2048 x 1536 pixels
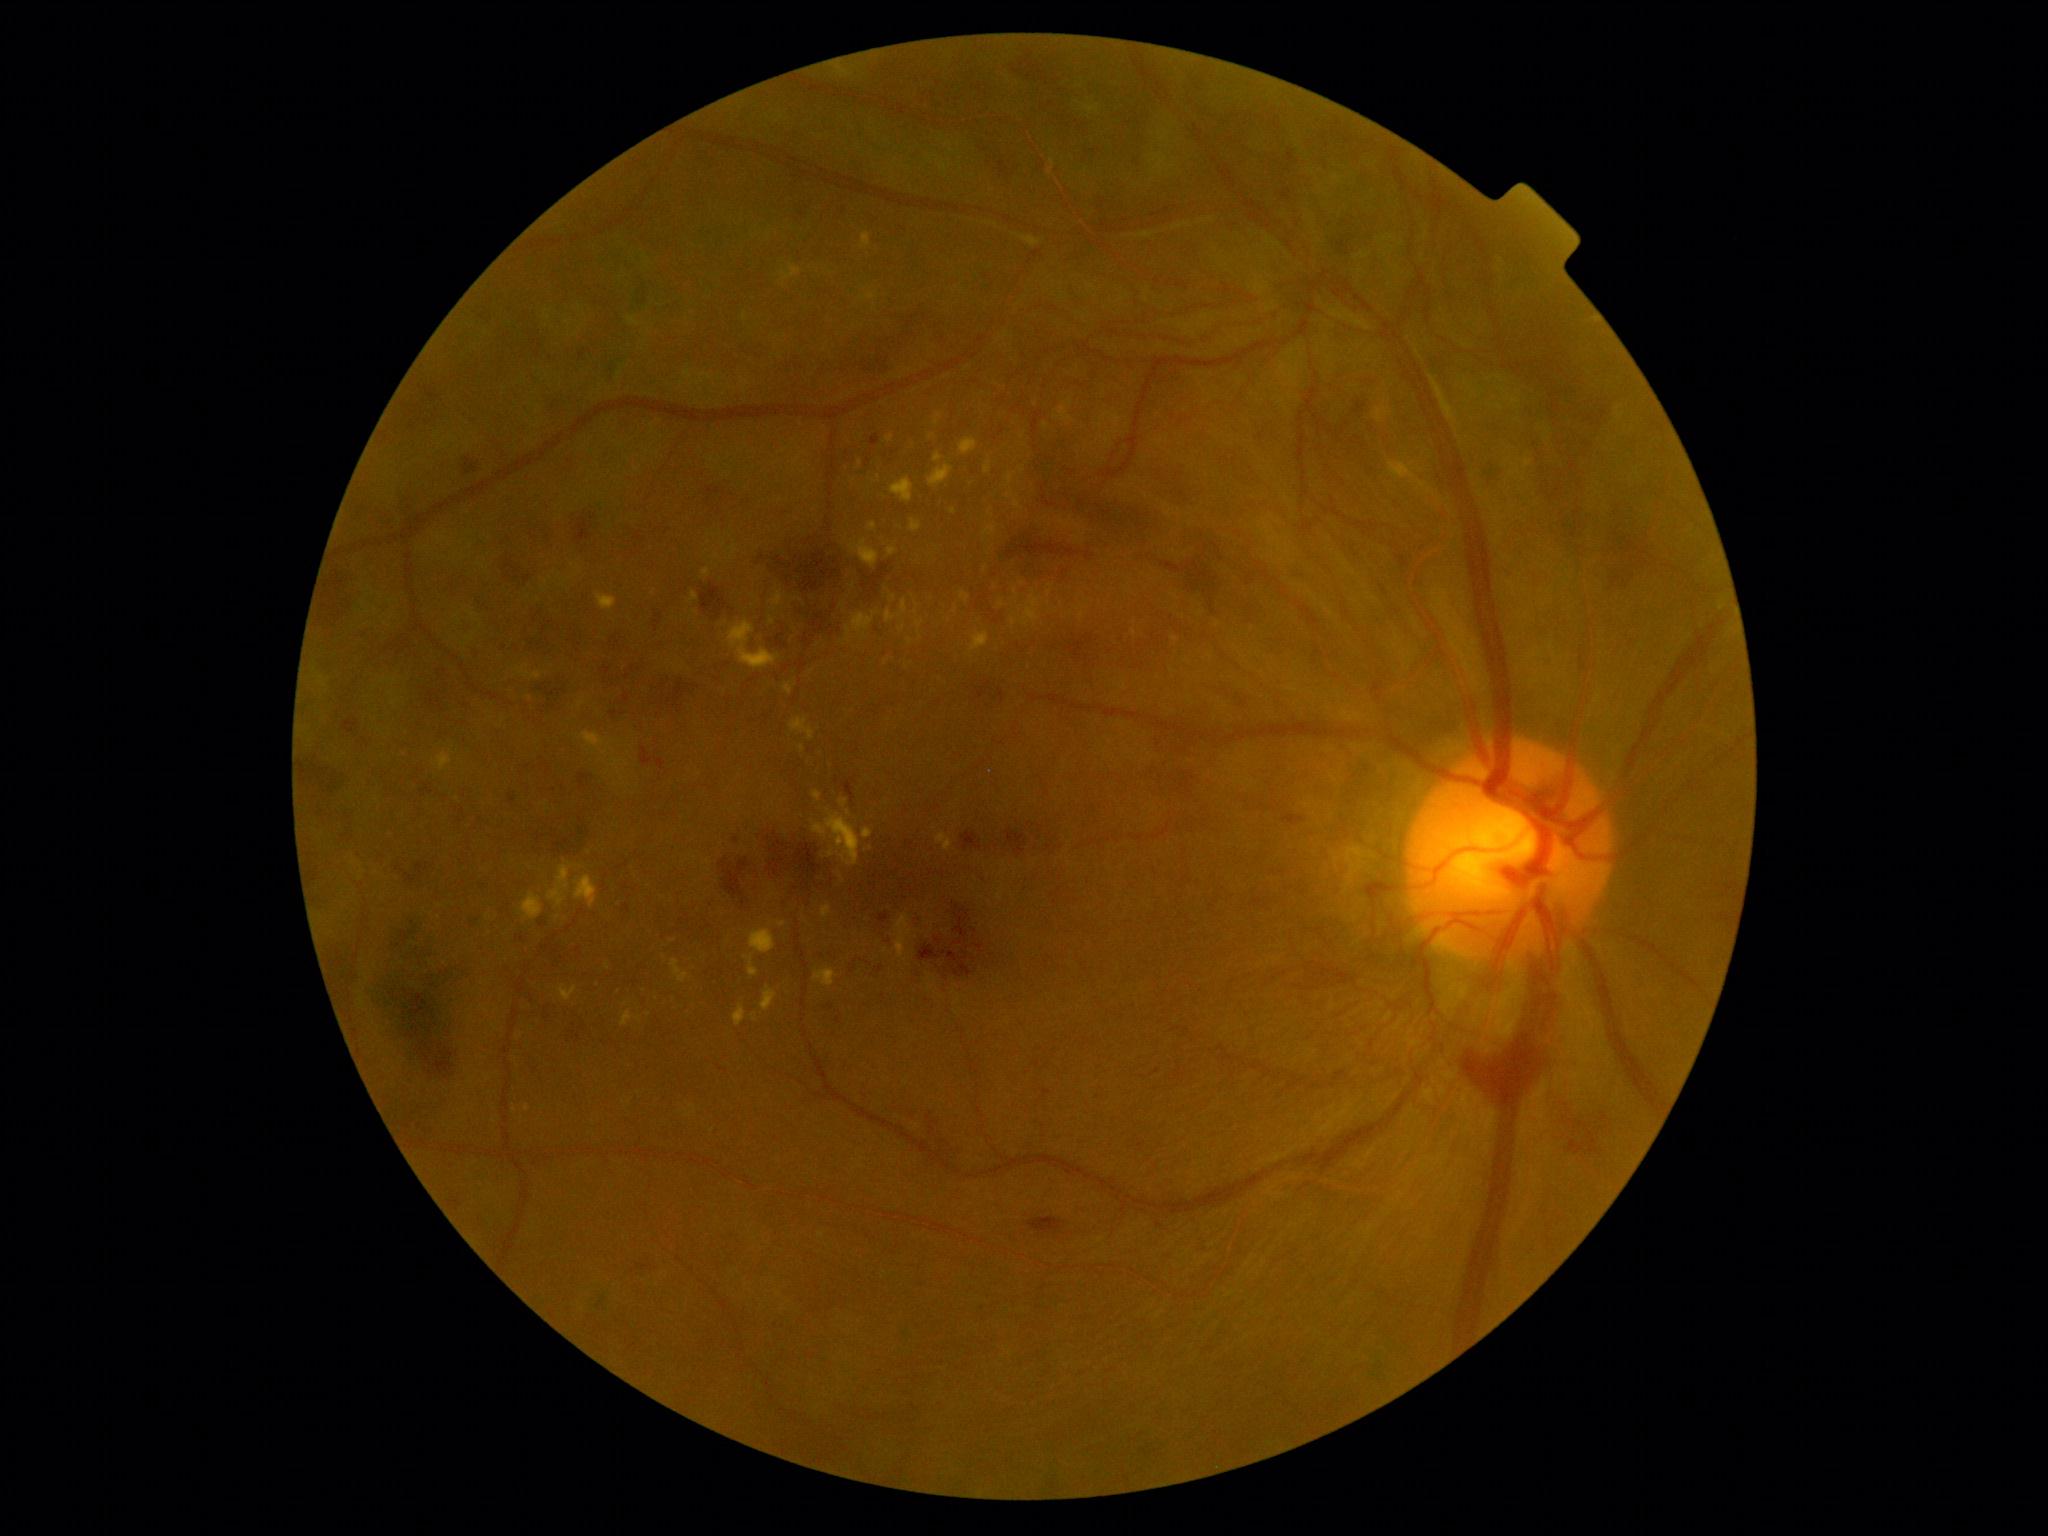 Diabetic retinopathy (DR) is grade 4 (PDR)
Representative lesions:
hard exudates (EXs) (more not shown): [x1=597, y1=593, x2=617, y2=611] | [x1=729, y1=620, x2=782, y2=670] | [x1=1085, y1=105, x2=1100, y2=115] | [x1=886, y1=600, x2=908, y2=624] | [x1=575, y1=876, x2=598, y2=908] | [x1=933, y1=453, x2=943, y2=463] | [x1=869, y1=523, x2=878, y2=531] | [x1=1006, y1=491, x2=1014, y2=498] | [x1=860, y1=294, x2=876, y2=301] | [x1=771, y1=591, x2=784, y2=607] | [x1=936, y1=832, x2=952, y2=852] | [x1=794, y1=598, x2=803, y2=602]
Additional small EXs near 986, 569 | 802, 749 | 1036, 404 | 842, 606 | 1023, 470 | 902, 629 | 664, 956 | 354, 863
hemorrhages (HEs) (more not shown): [x1=612, y1=704, x2=631, y2=722] | [x1=624, y1=693, x2=630, y2=703] | [x1=1006, y1=829, x2=1028, y2=856] | [x1=777, y1=634, x2=789, y2=649] | [x1=754, y1=524, x2=895, y2=640] | [x1=1539, y1=463, x2=1587, y2=547] | [x1=661, y1=679, x2=700, y2=713] | [x1=915, y1=902, x2=992, y2=985] | [x1=1496, y1=352, x2=1574, y2=388] | [x1=398, y1=856, x2=431, y2=885] | [x1=1332, y1=209, x2=1383, y2=255] | [x1=703, y1=485, x2=731, y2=513] | [x1=301, y1=756, x2=350, y2=795] | [x1=535, y1=609, x2=554, y2=634] | [x1=865, y1=344, x2=896, y2=379]
microaneurysms (MAs) (more not shown): [x1=426, y1=692, x2=435, y2=706] | [x1=362, y1=738, x2=369, y2=746] | [x1=1353, y1=401, x2=1367, y2=414] | [x1=1602, y1=1113, x2=1608, y2=1121] | [x1=474, y1=654, x2=481, y2=663] | [x1=476, y1=596, x2=494, y2=614] | [x1=449, y1=1199, x2=462, y2=1209] | [x1=1294, y1=573, x2=1304, y2=583] | [x1=1723, y1=915, x2=1731, y2=922] | [x1=1287, y1=813, x2=1303, y2=823] | [x1=978, y1=682, x2=992, y2=699] | [x1=359, y1=630, x2=367, y2=640]
Additional small MAs near 890, 941 | 736, 840 | 744, 904 | 1606, 1128